Acquired on the Clarity RetCam 3 · infant wide-field retinal image.
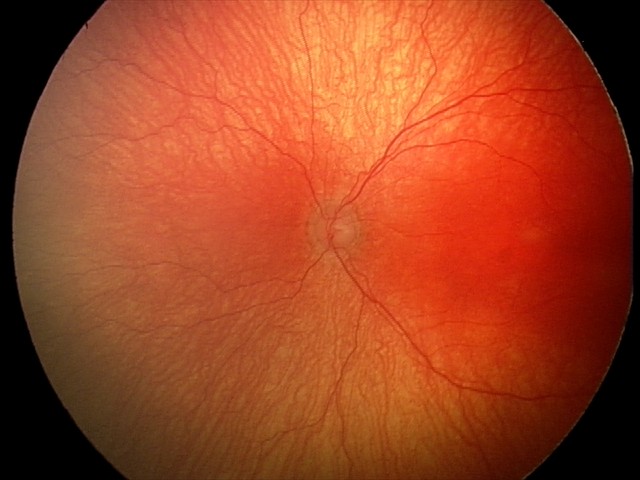
Examination diagnosed as aggressive retinopathy of prematurity.
With plus disease.